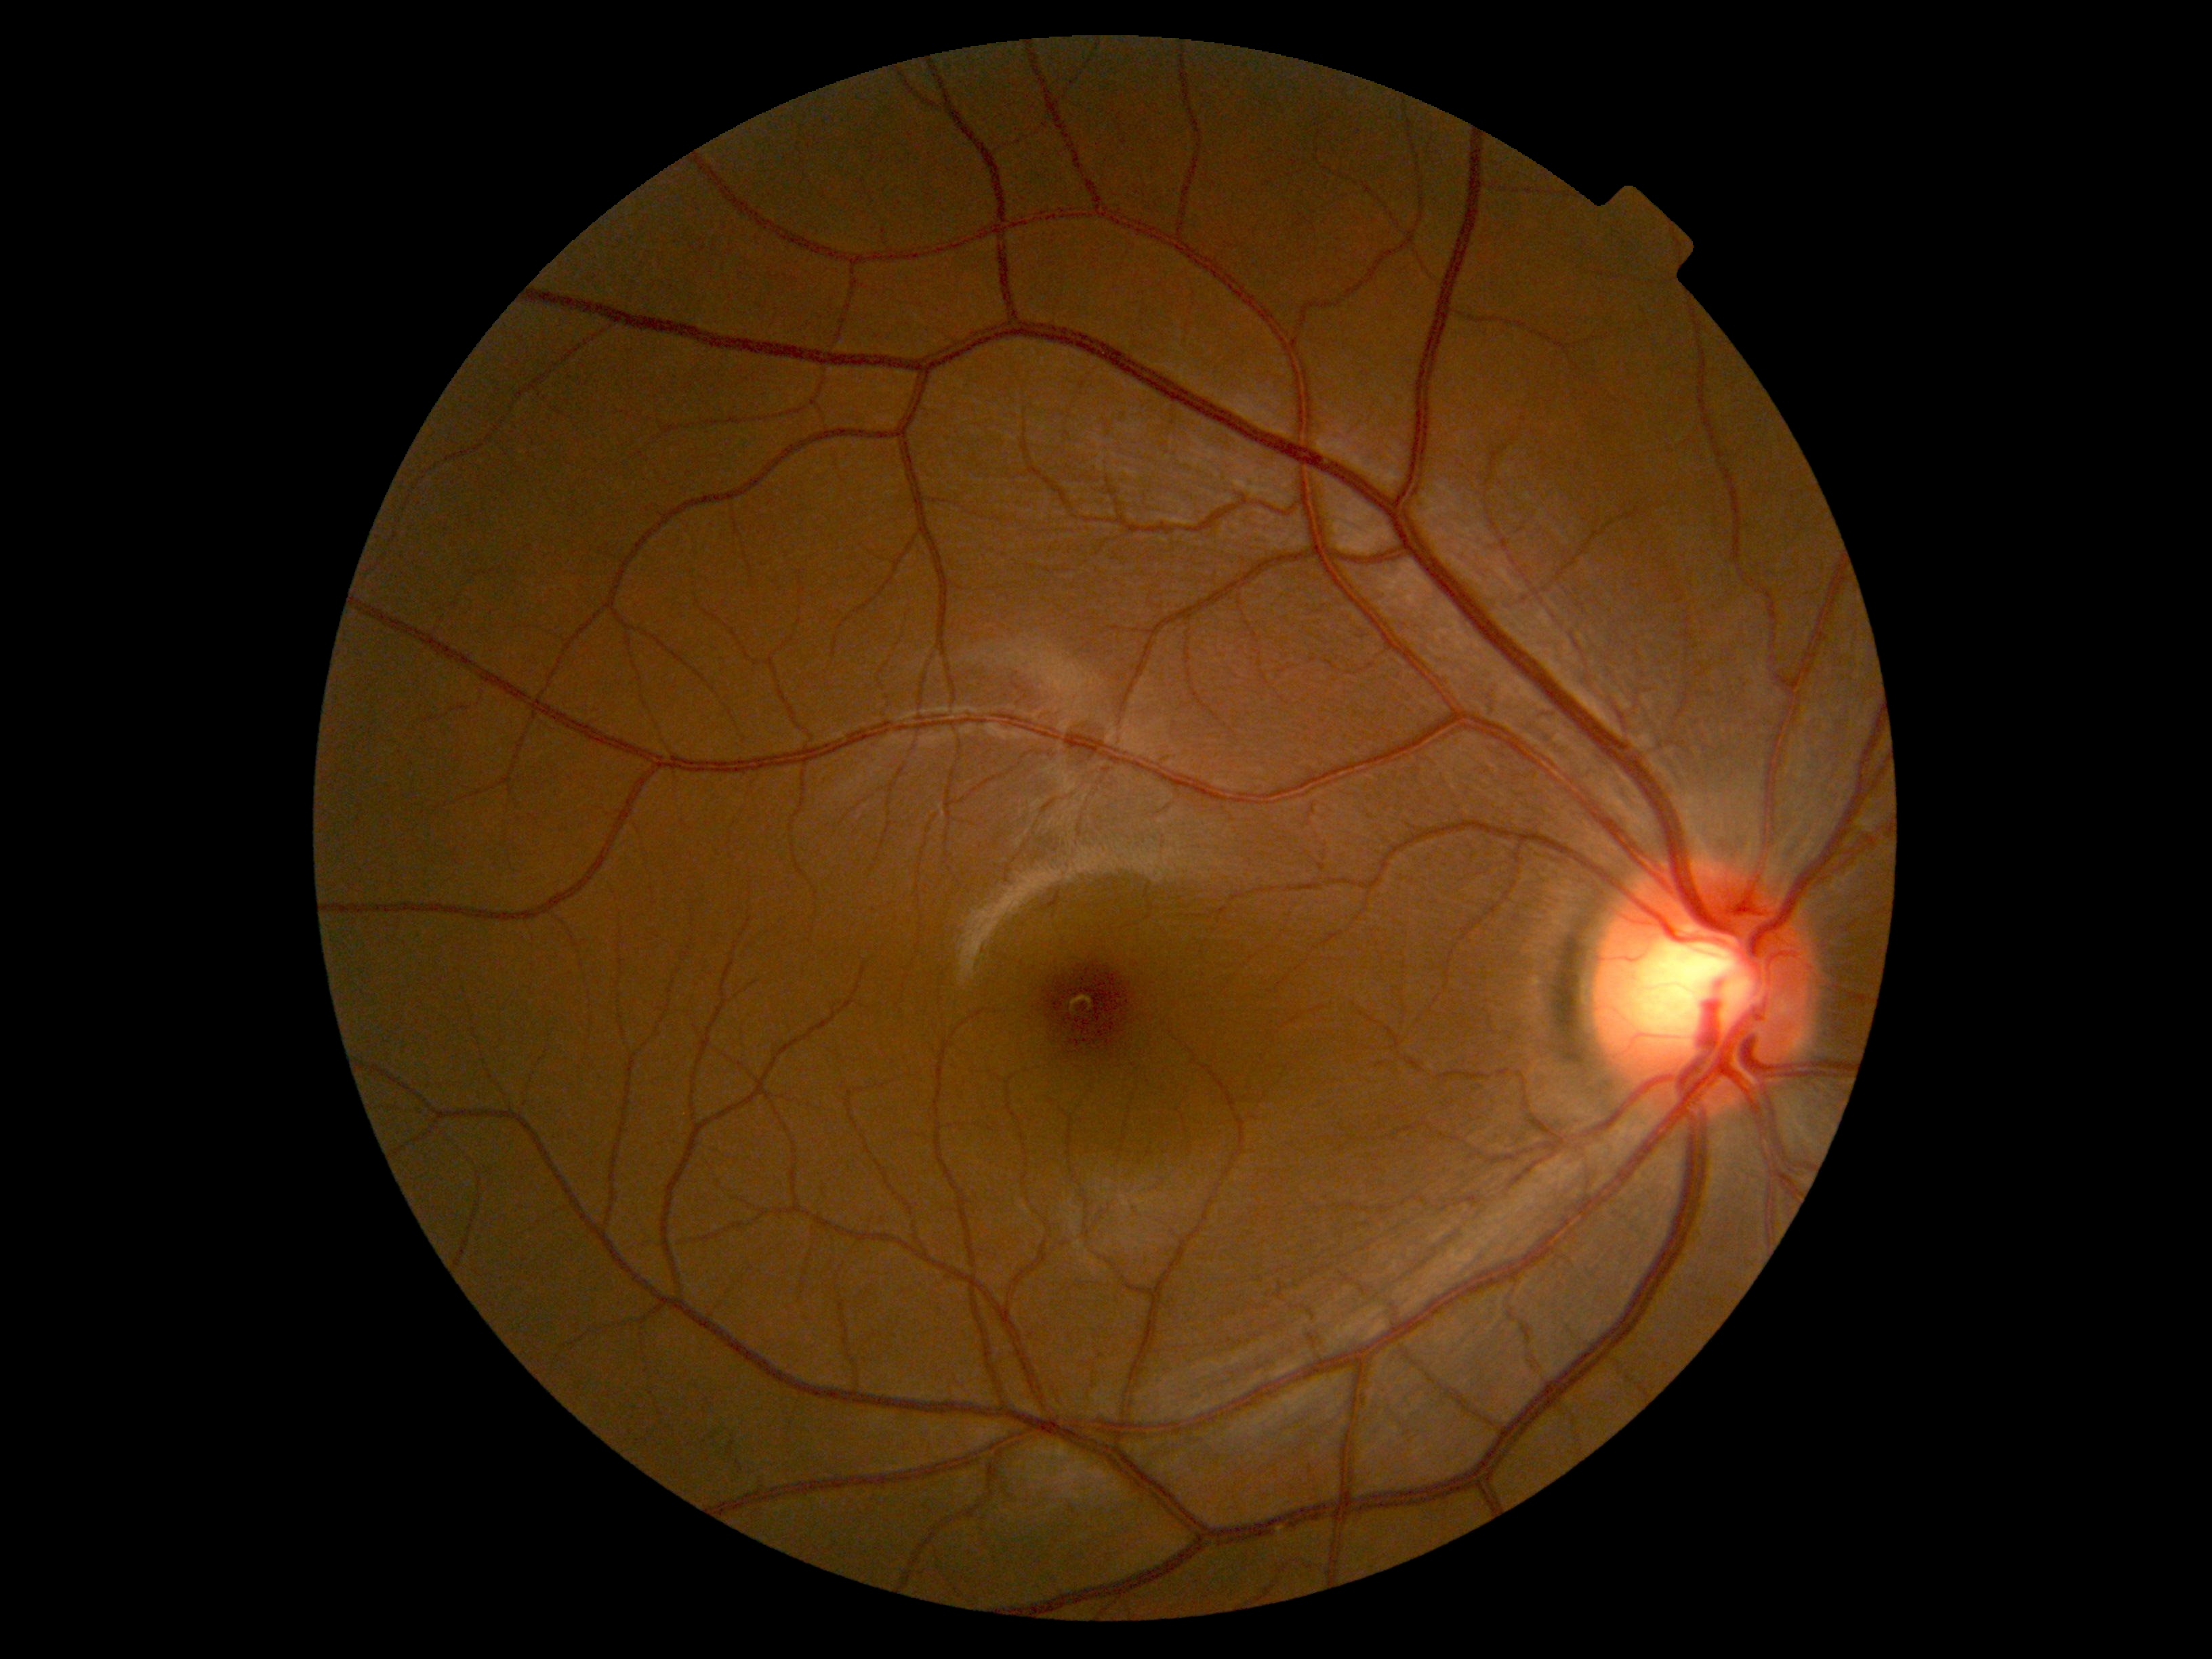
No DR findings. Diabetic retinopathy (DR): grade 0 (no apparent retinopathy).